Retinal fundus photograph
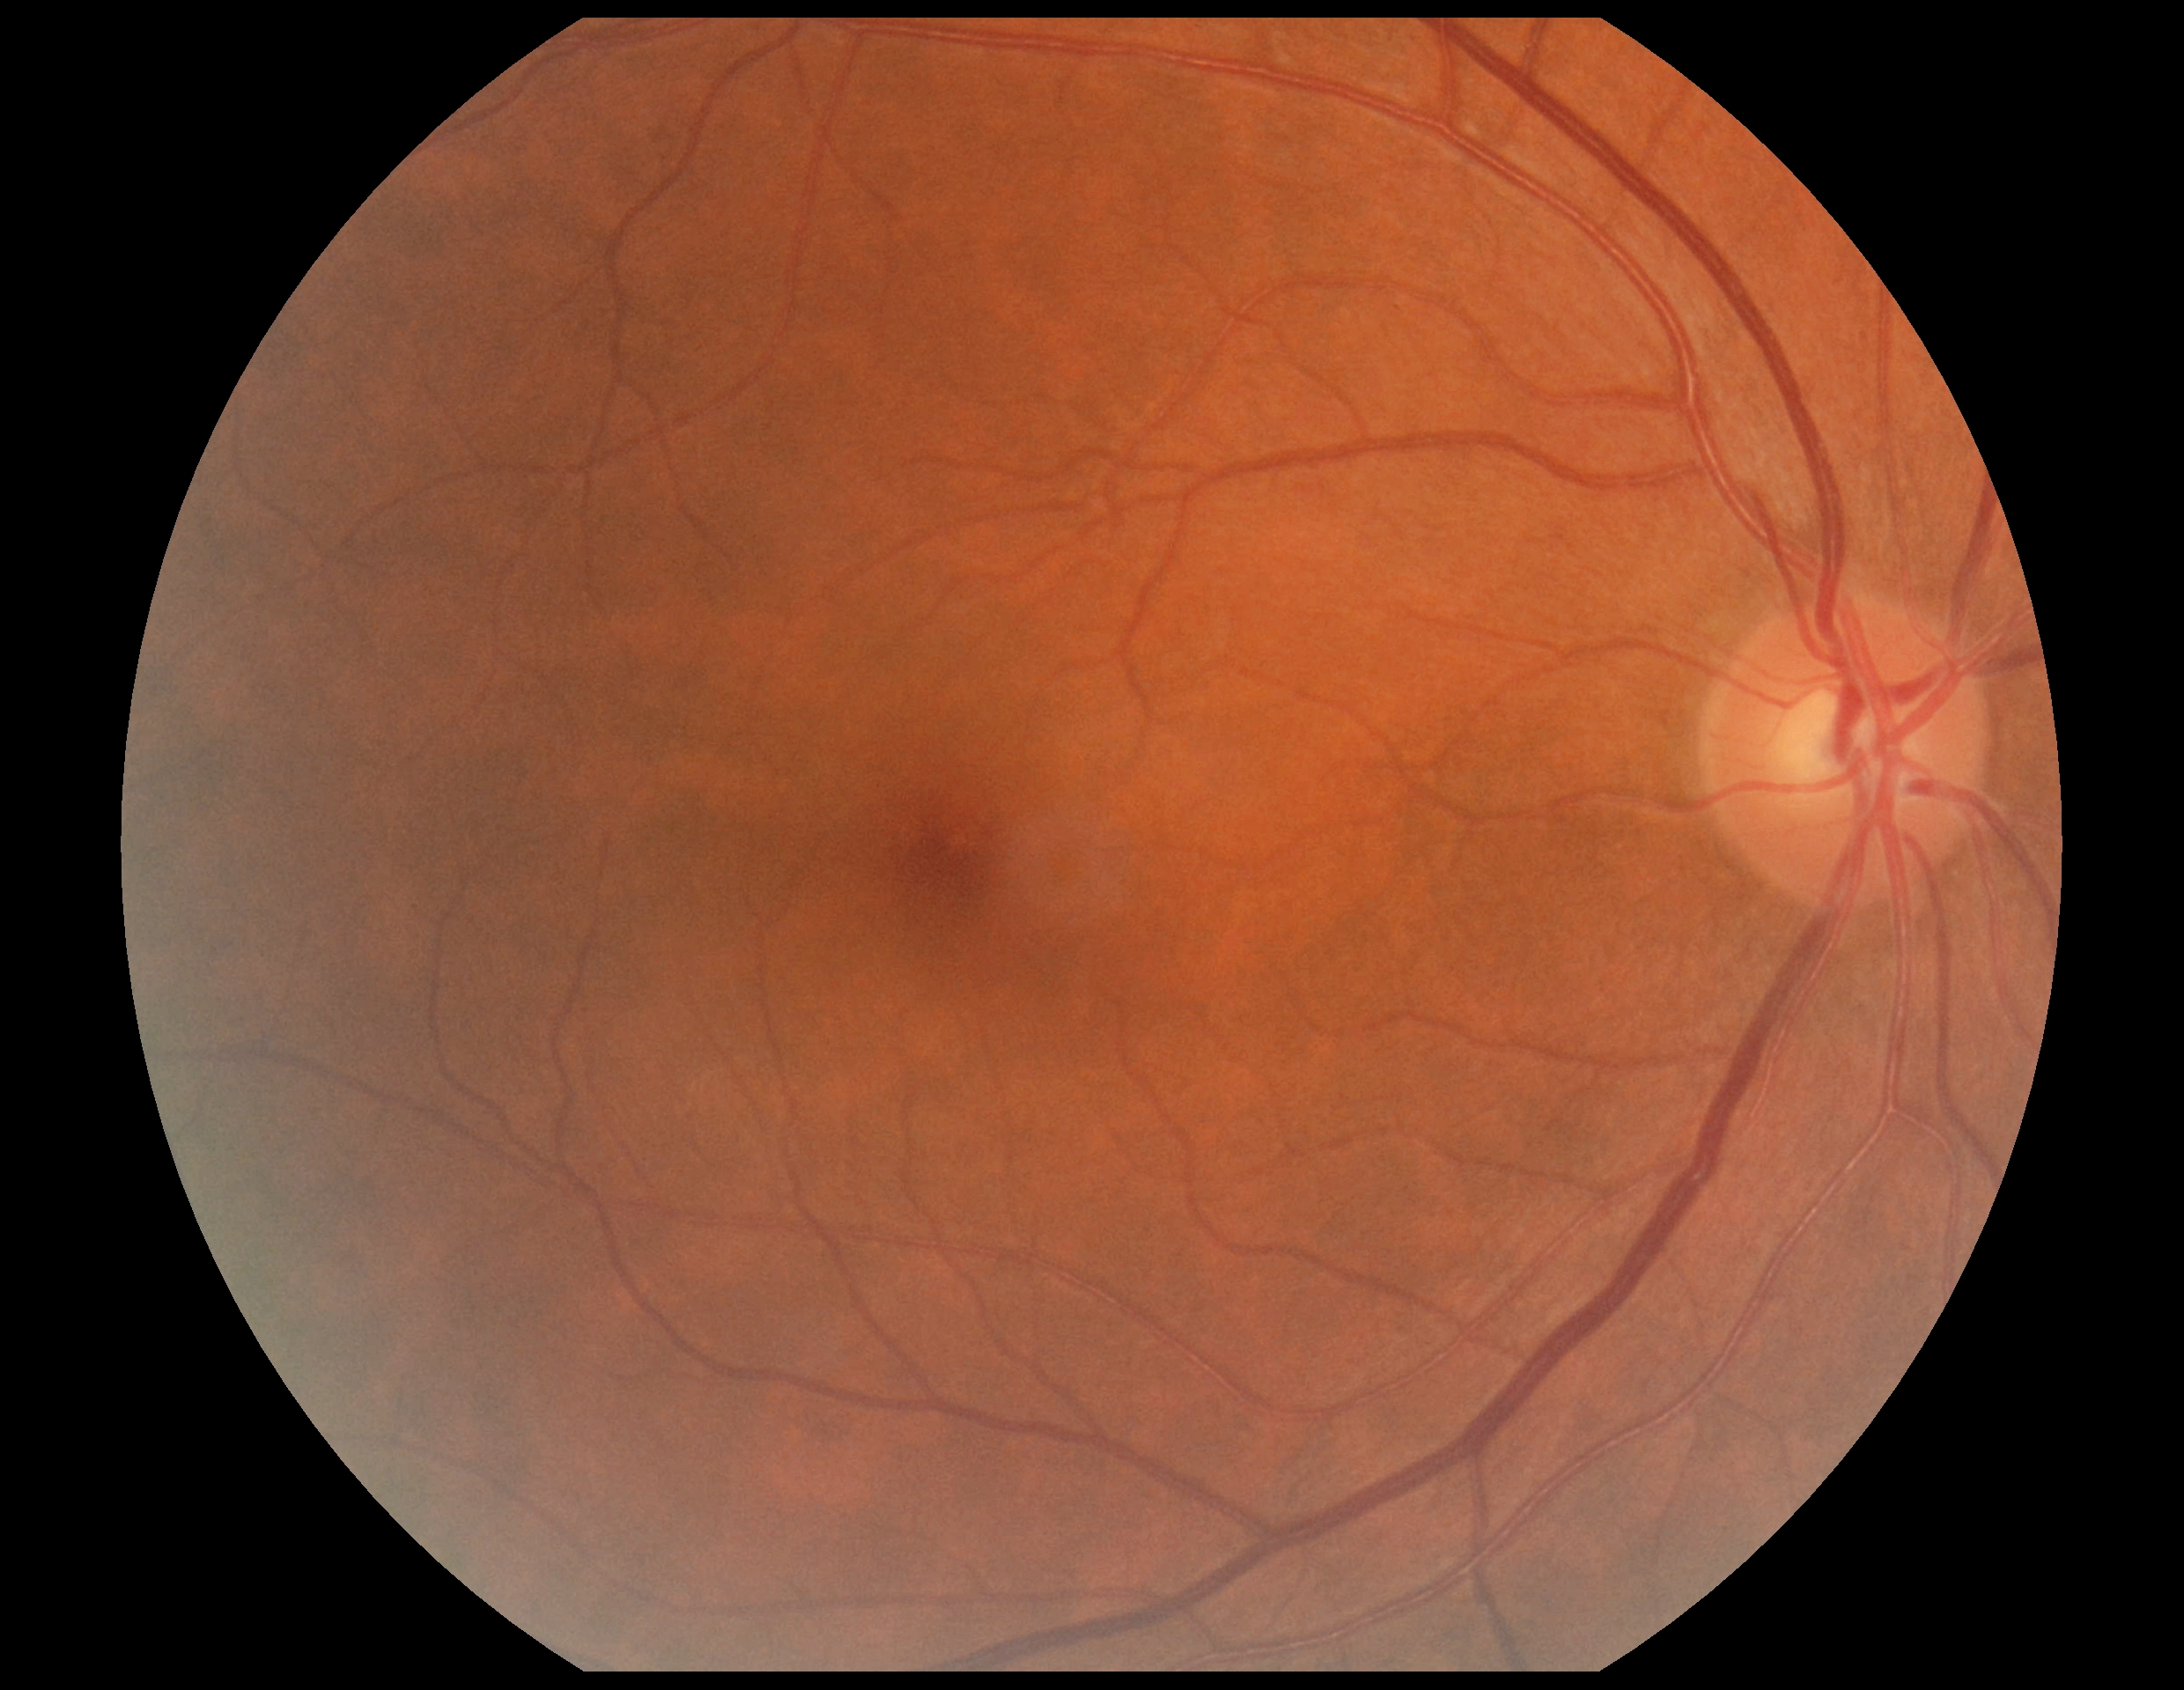 DR stage is no apparent diabetic retinopathy (grade 0) — no visible signs of diabetic retinopathy.
No diabetic retinal disease findings.